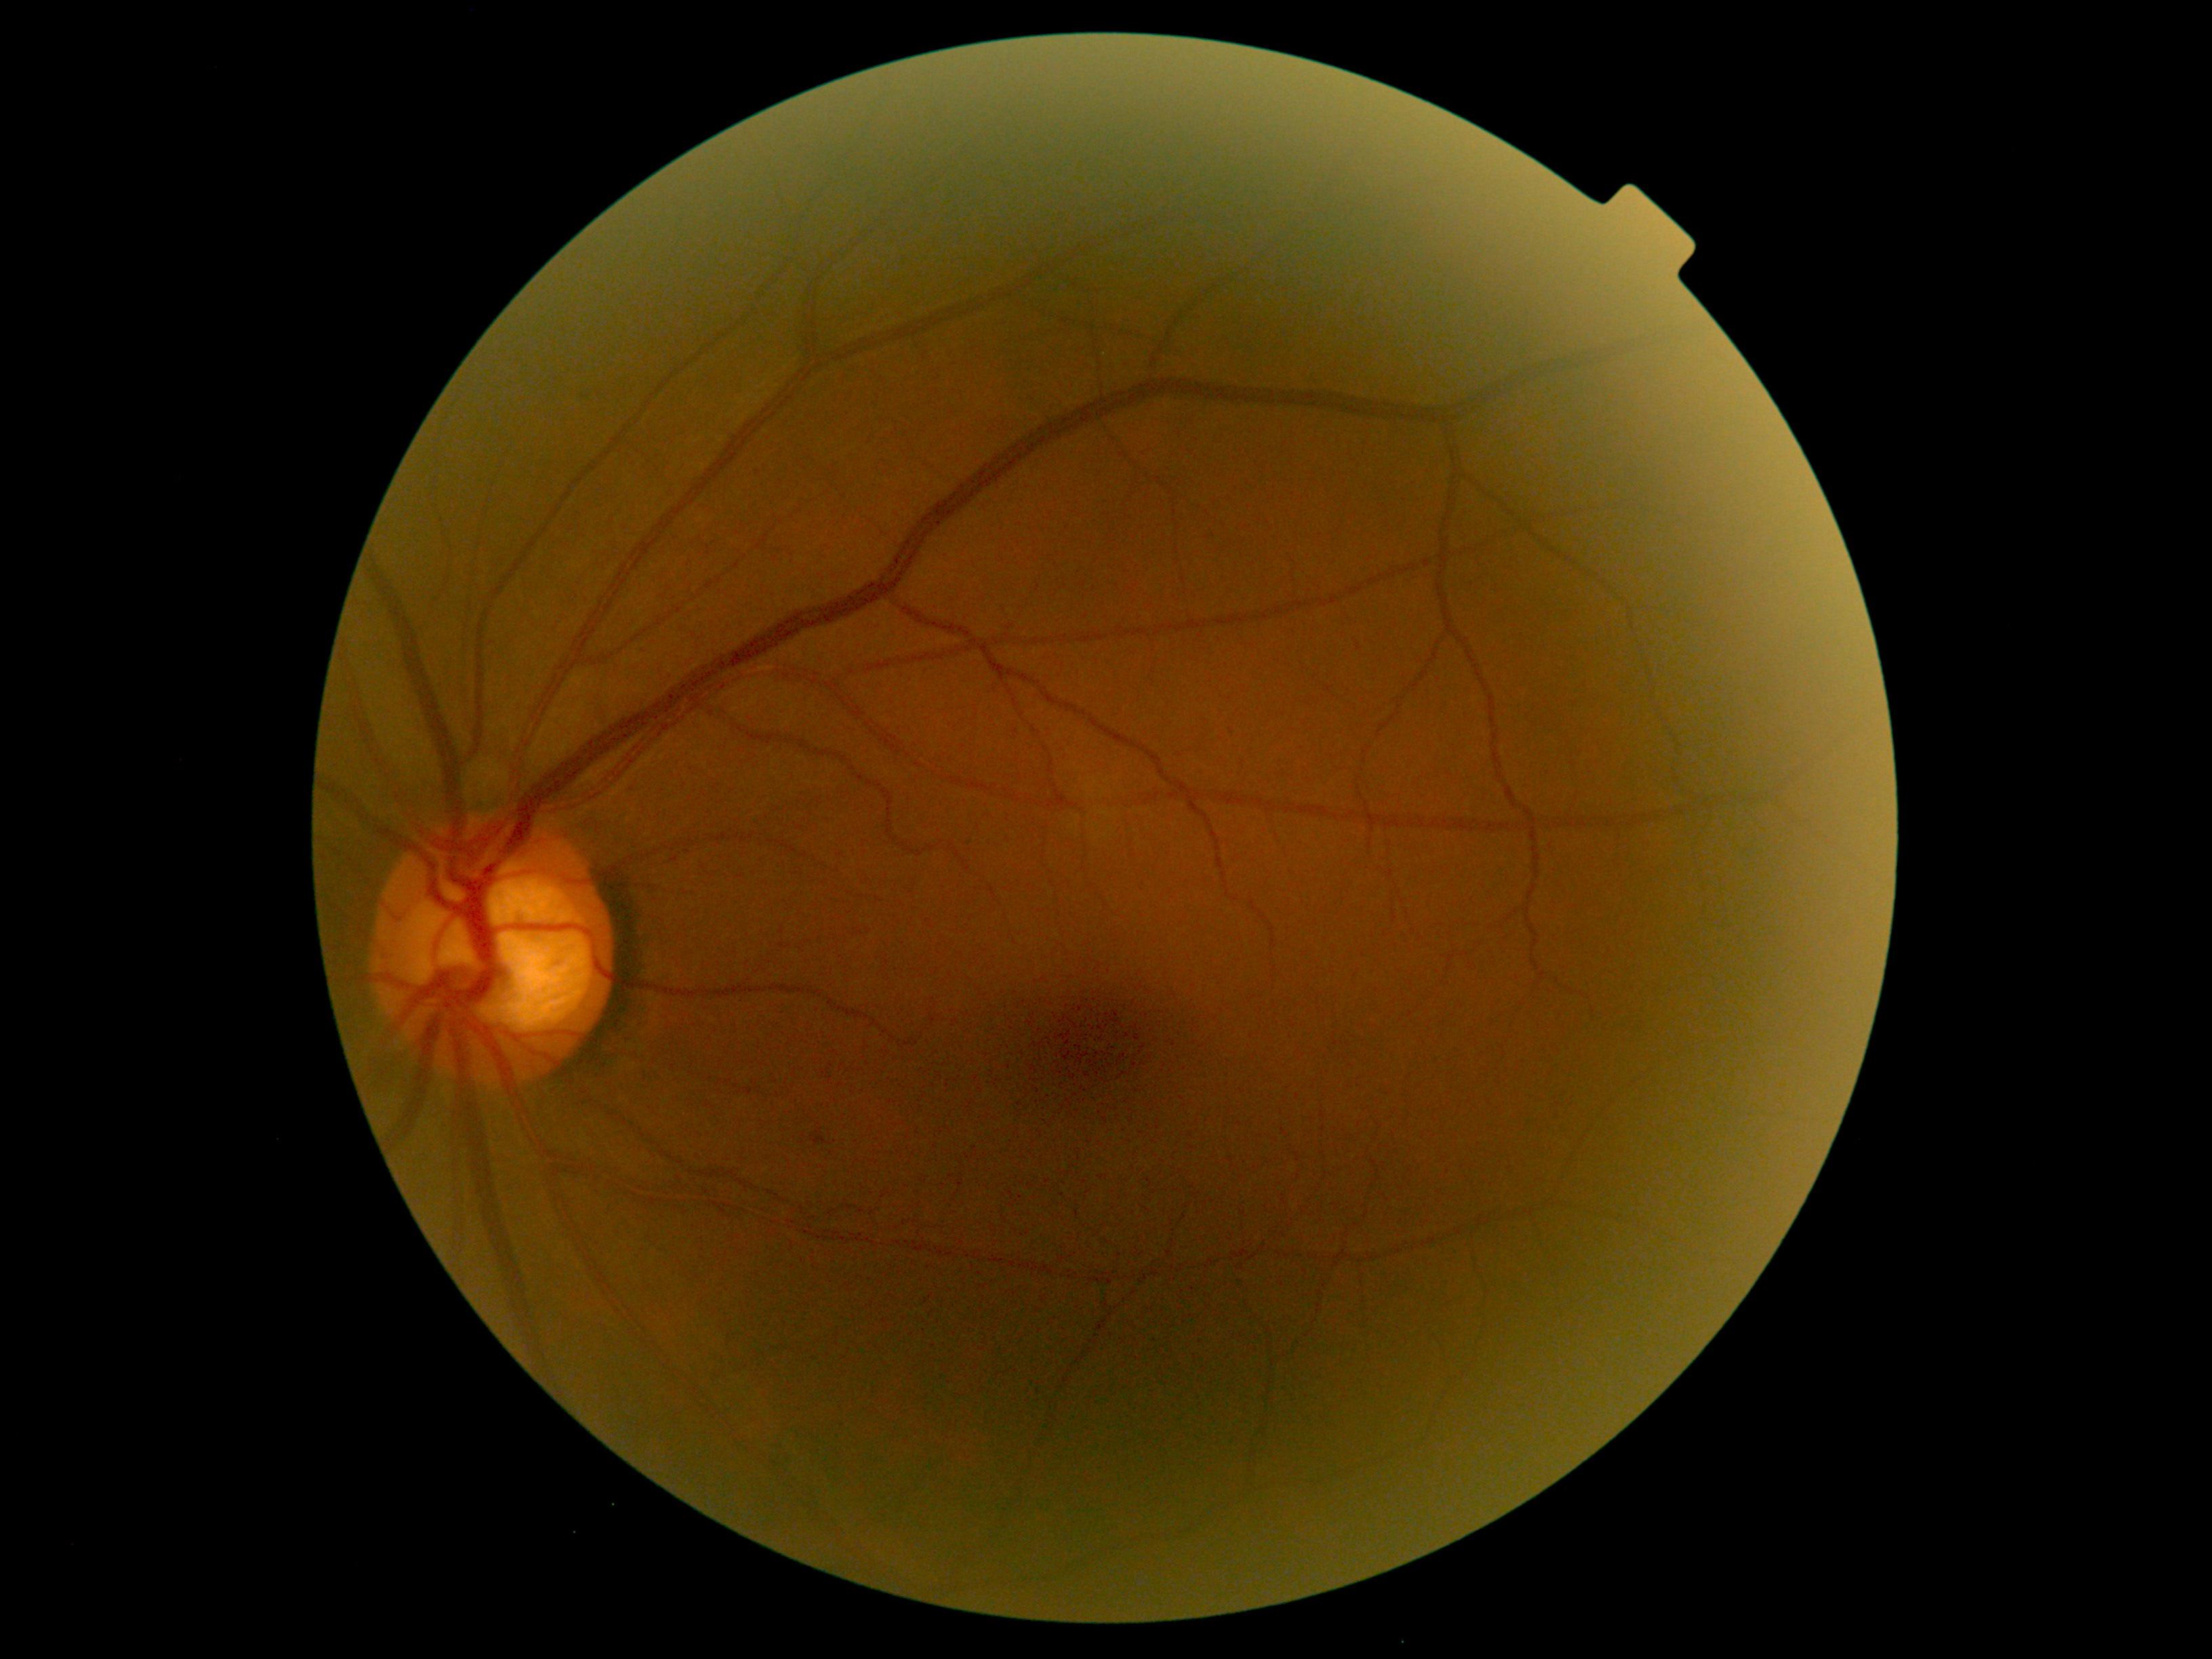

Retinopathy is 1.